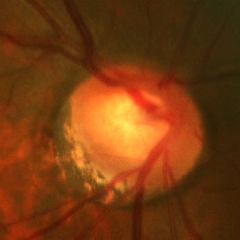

Q: What is the glaucoma diagnosis?
A: Advanced-stage glaucoma.